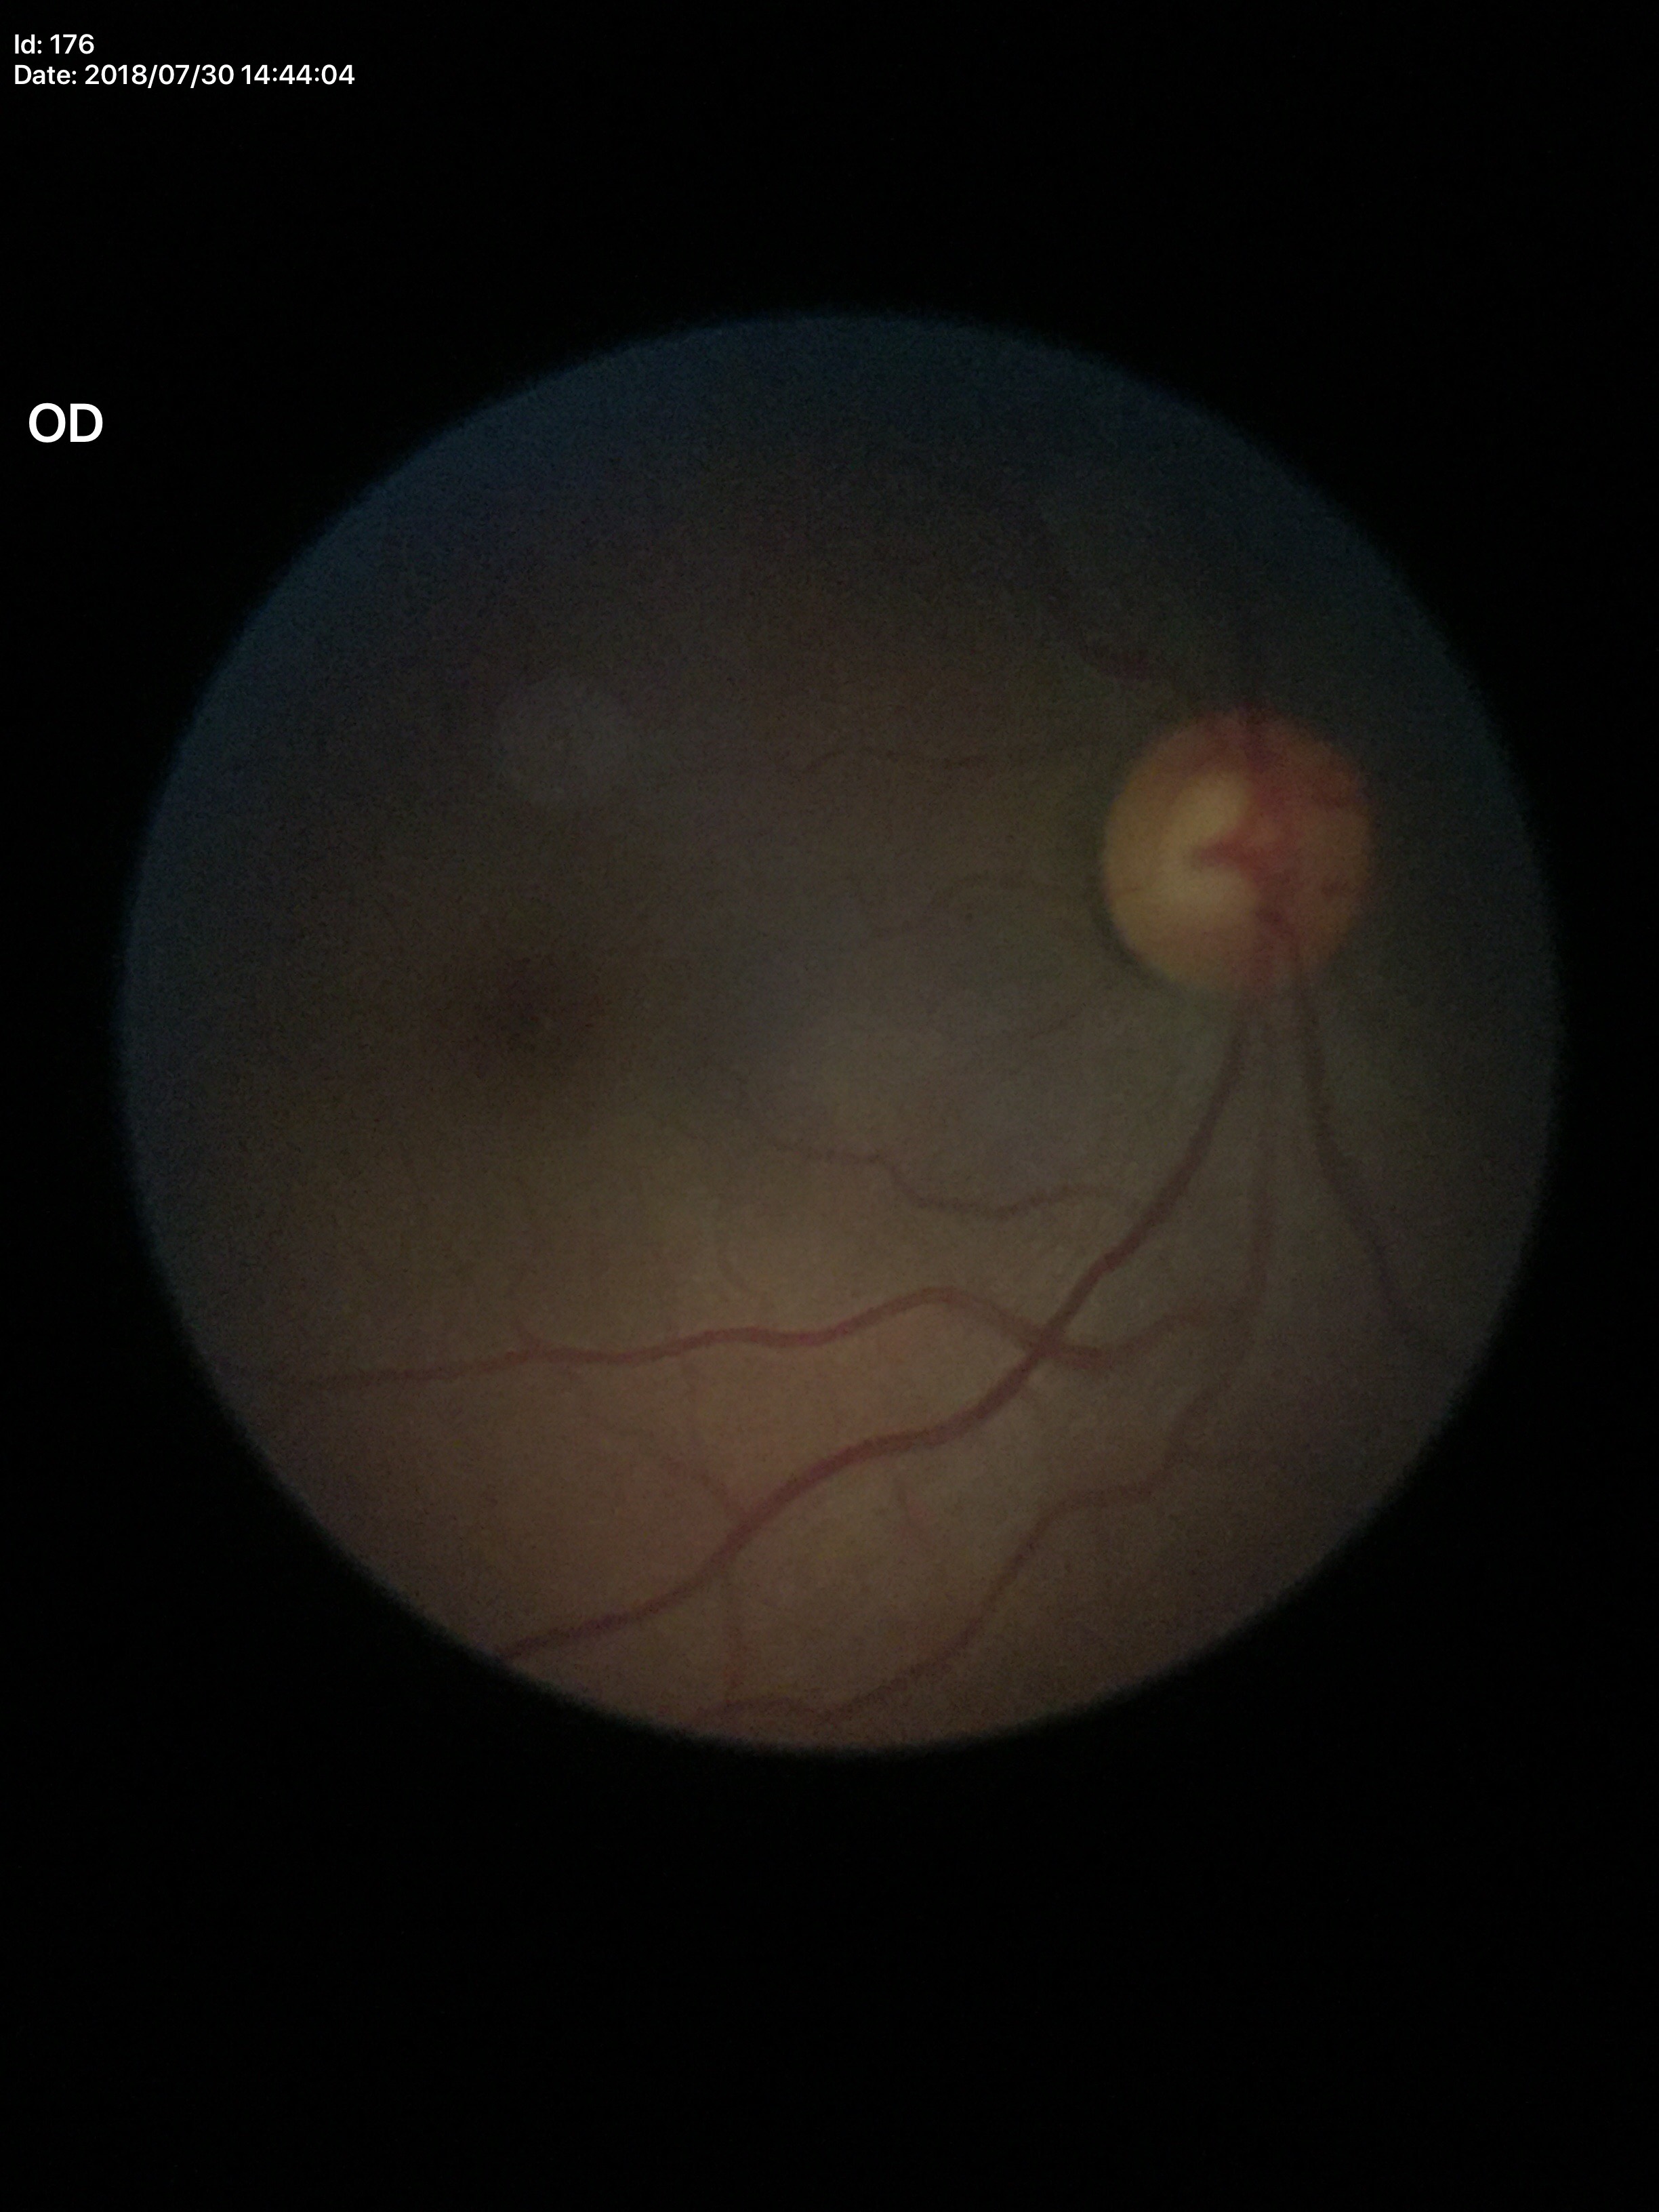
Q: What is the VCDR?
A: 0.56
Q: What is the glaucoma assessment?
A: negative (one of five ophthalmologists flagged glaucoma suspect)